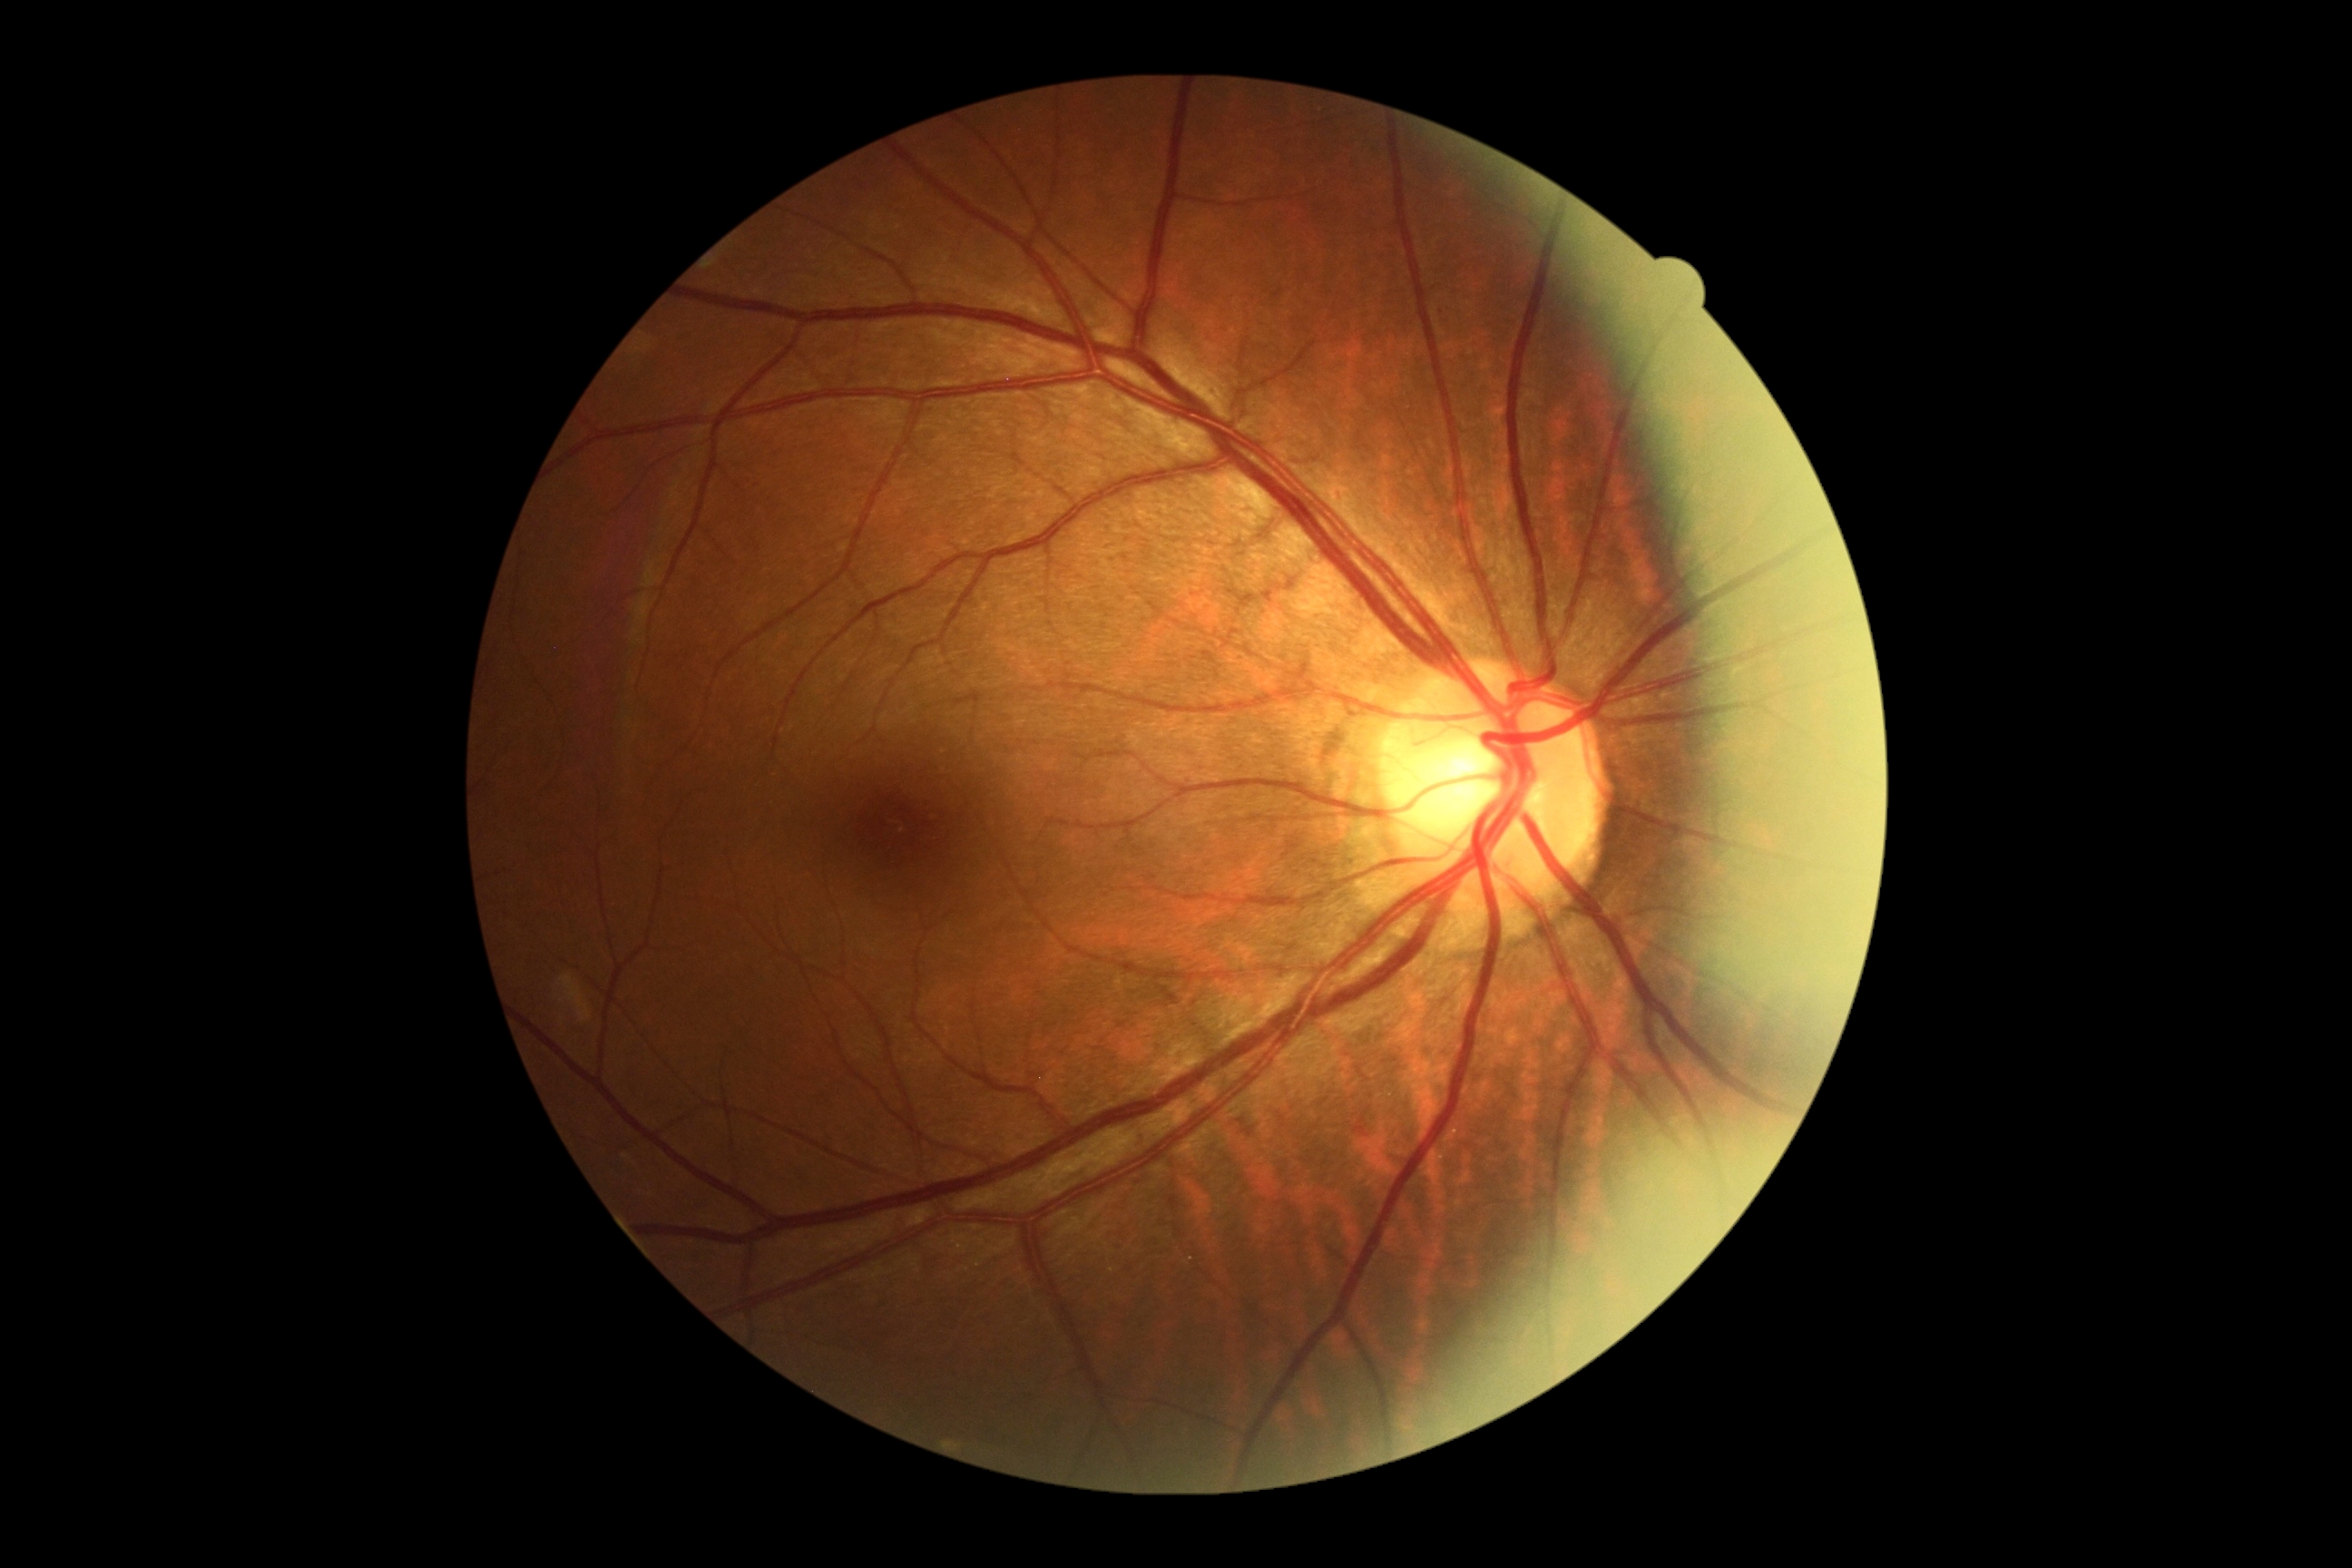

Diabetic retinopathy: no apparent diabetic retinopathy (grade 0).